Davis DR grading
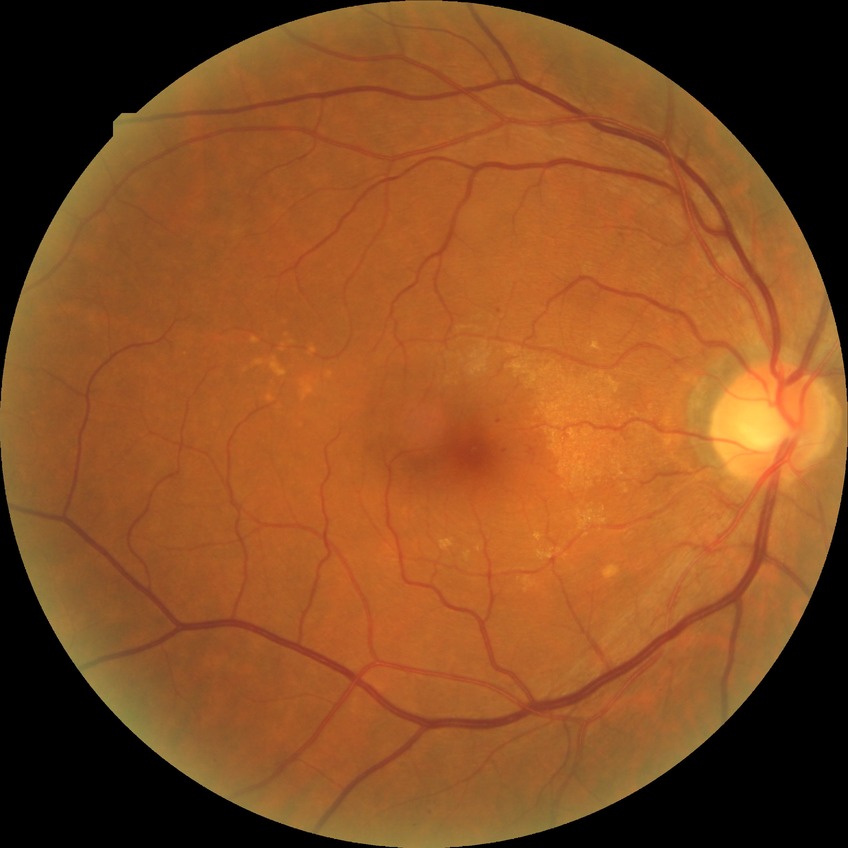 Diabetic retinopathy (DR) is SDR (simple diabetic retinopathy).